Without pupil dilation:
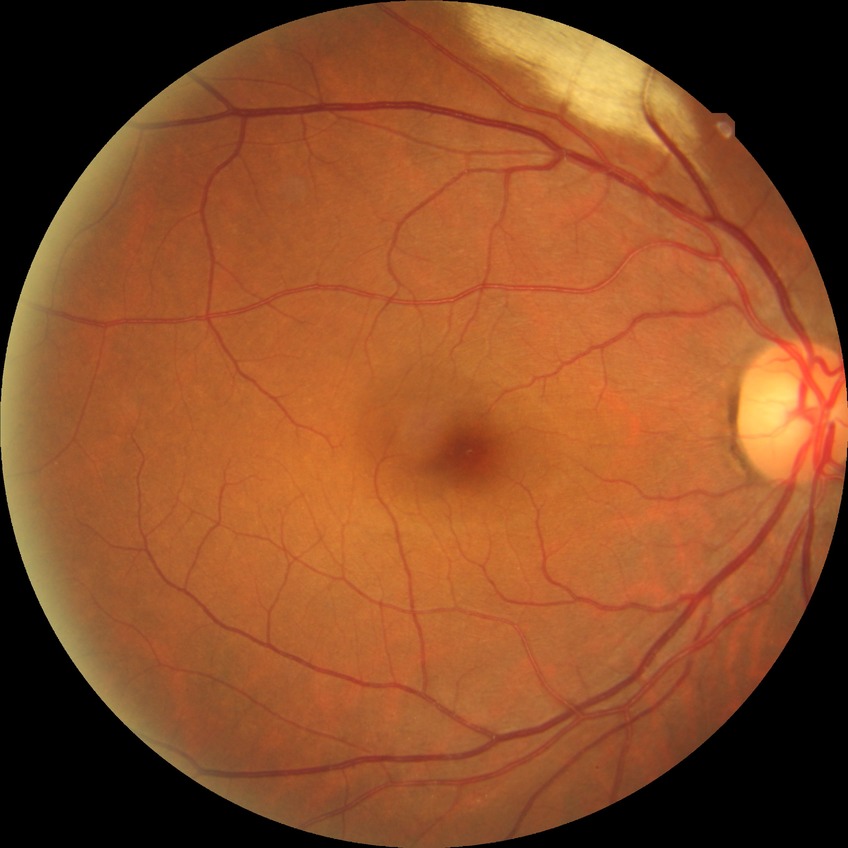 Modified Davis classification is no diabetic retinopathy.